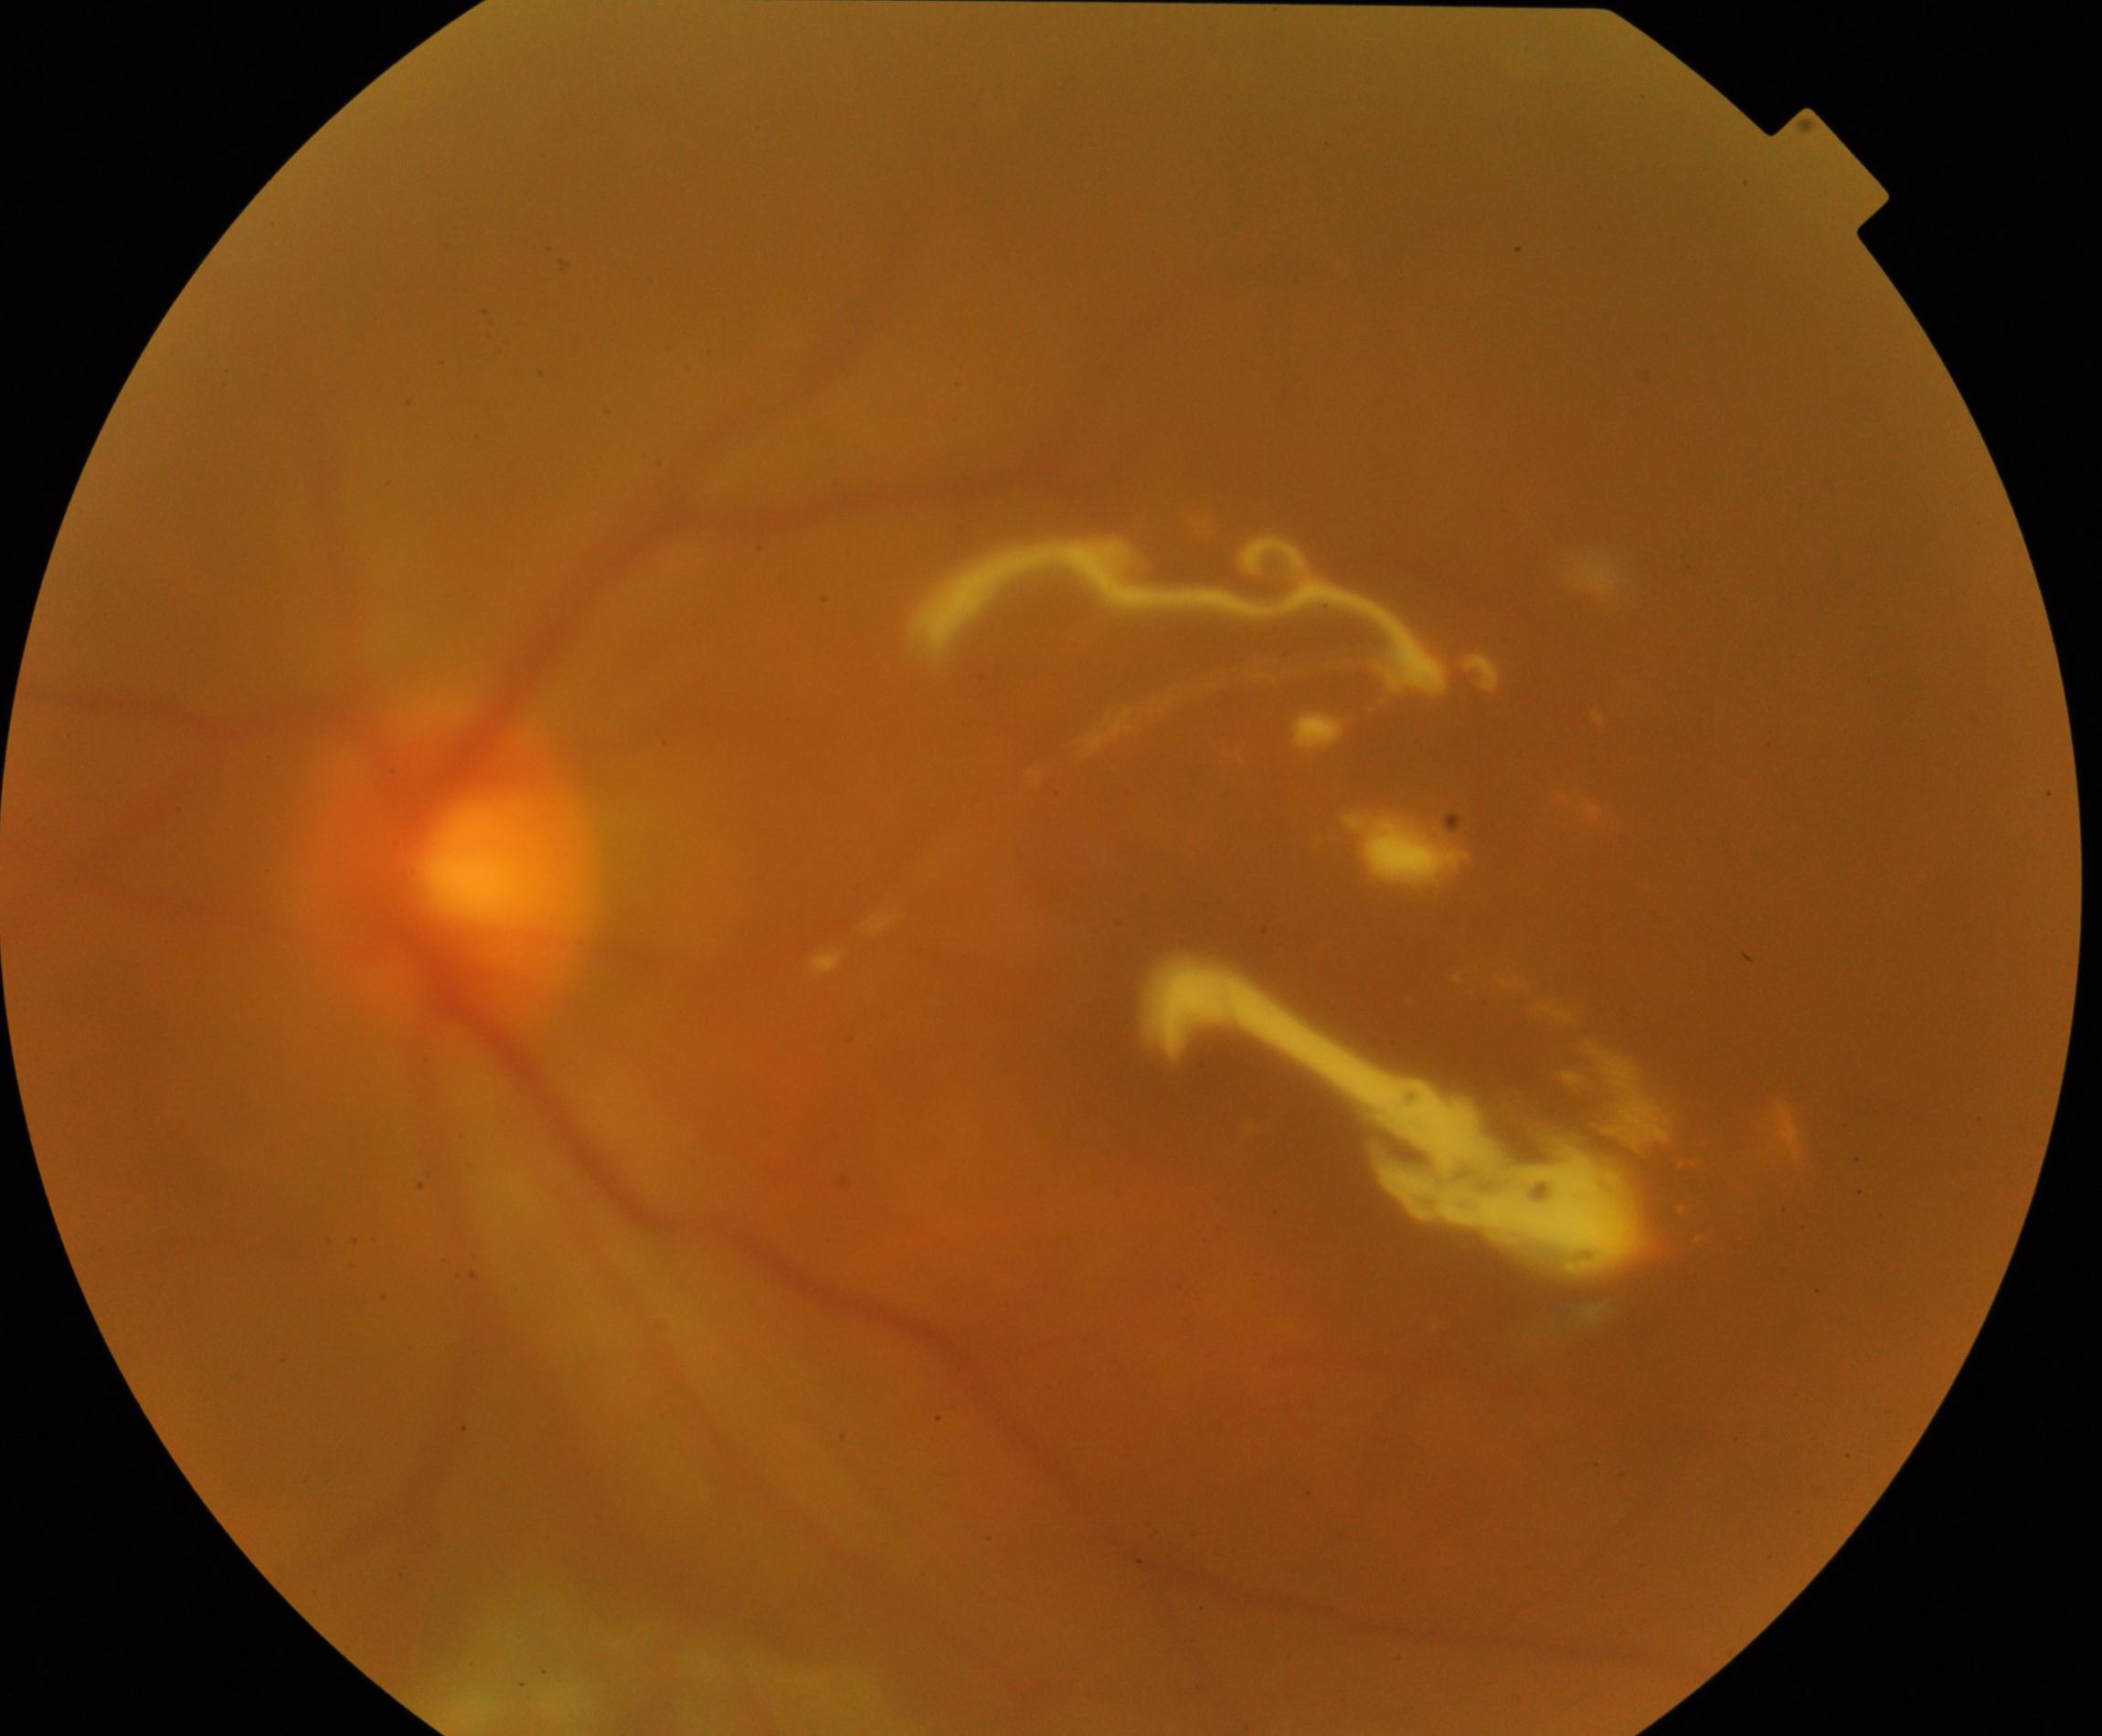 Findings: silicone oil in the eye.